DR severity per modified Davis staging, 848x848, NIDEK AFC-230, color fundus photograph, without pupil dilation:
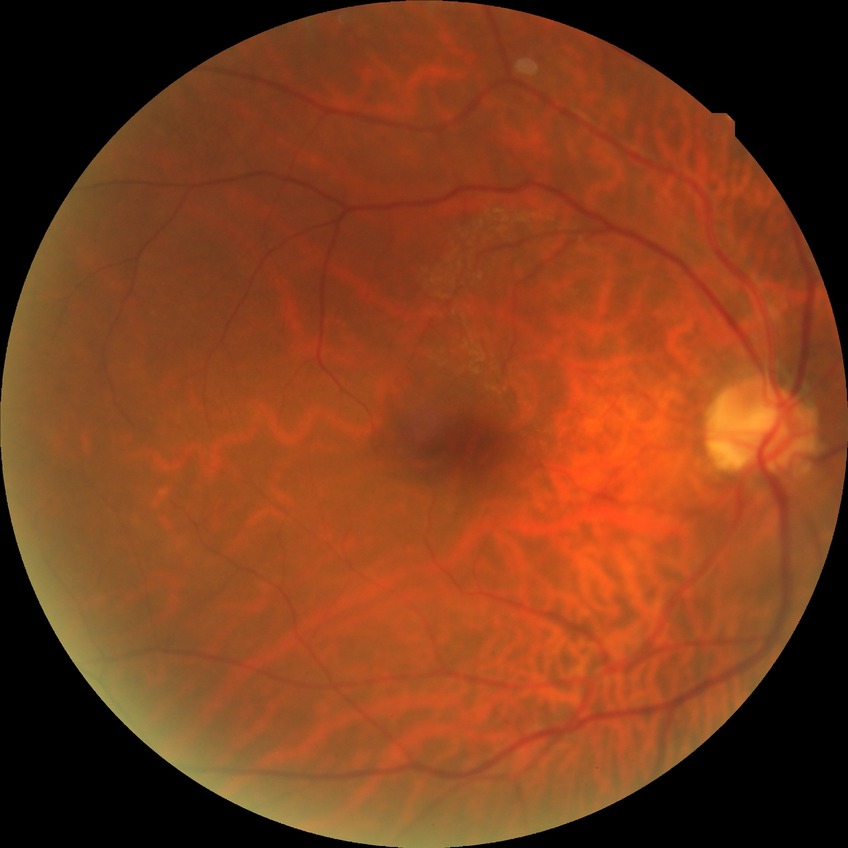 {"davis_grade": "no diabetic retinopathy"}